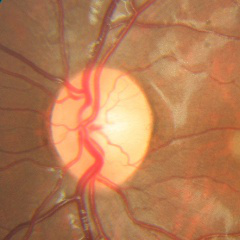
Assessment = no signs of glaucoma.